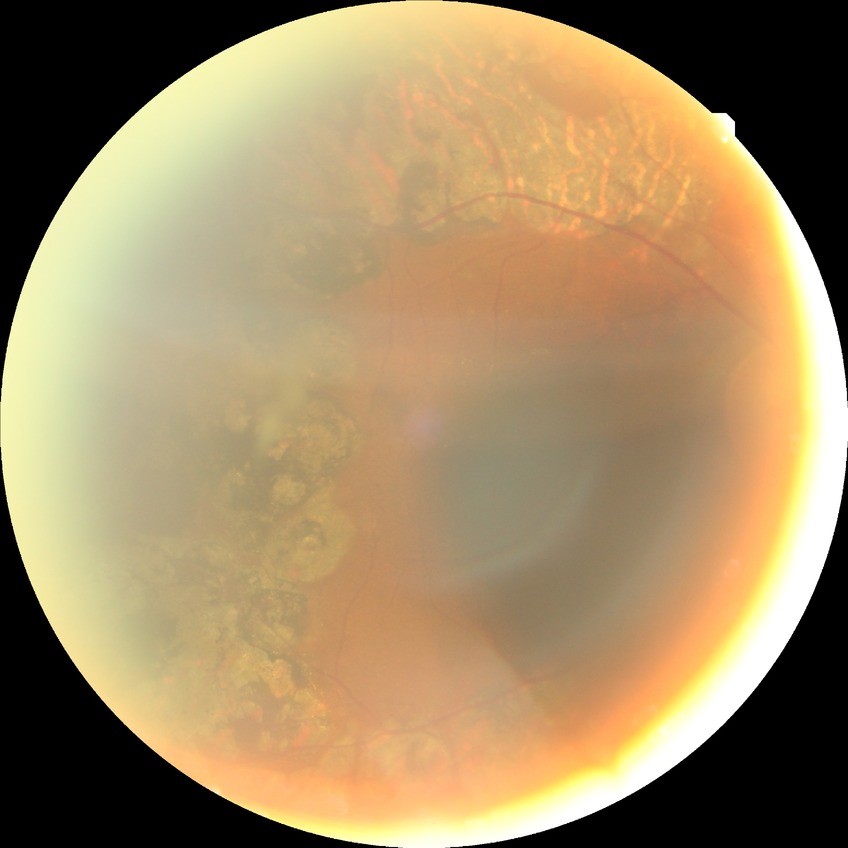 Diabetic retinopathy (DR) is PDR (proliferative diabetic retinopathy).